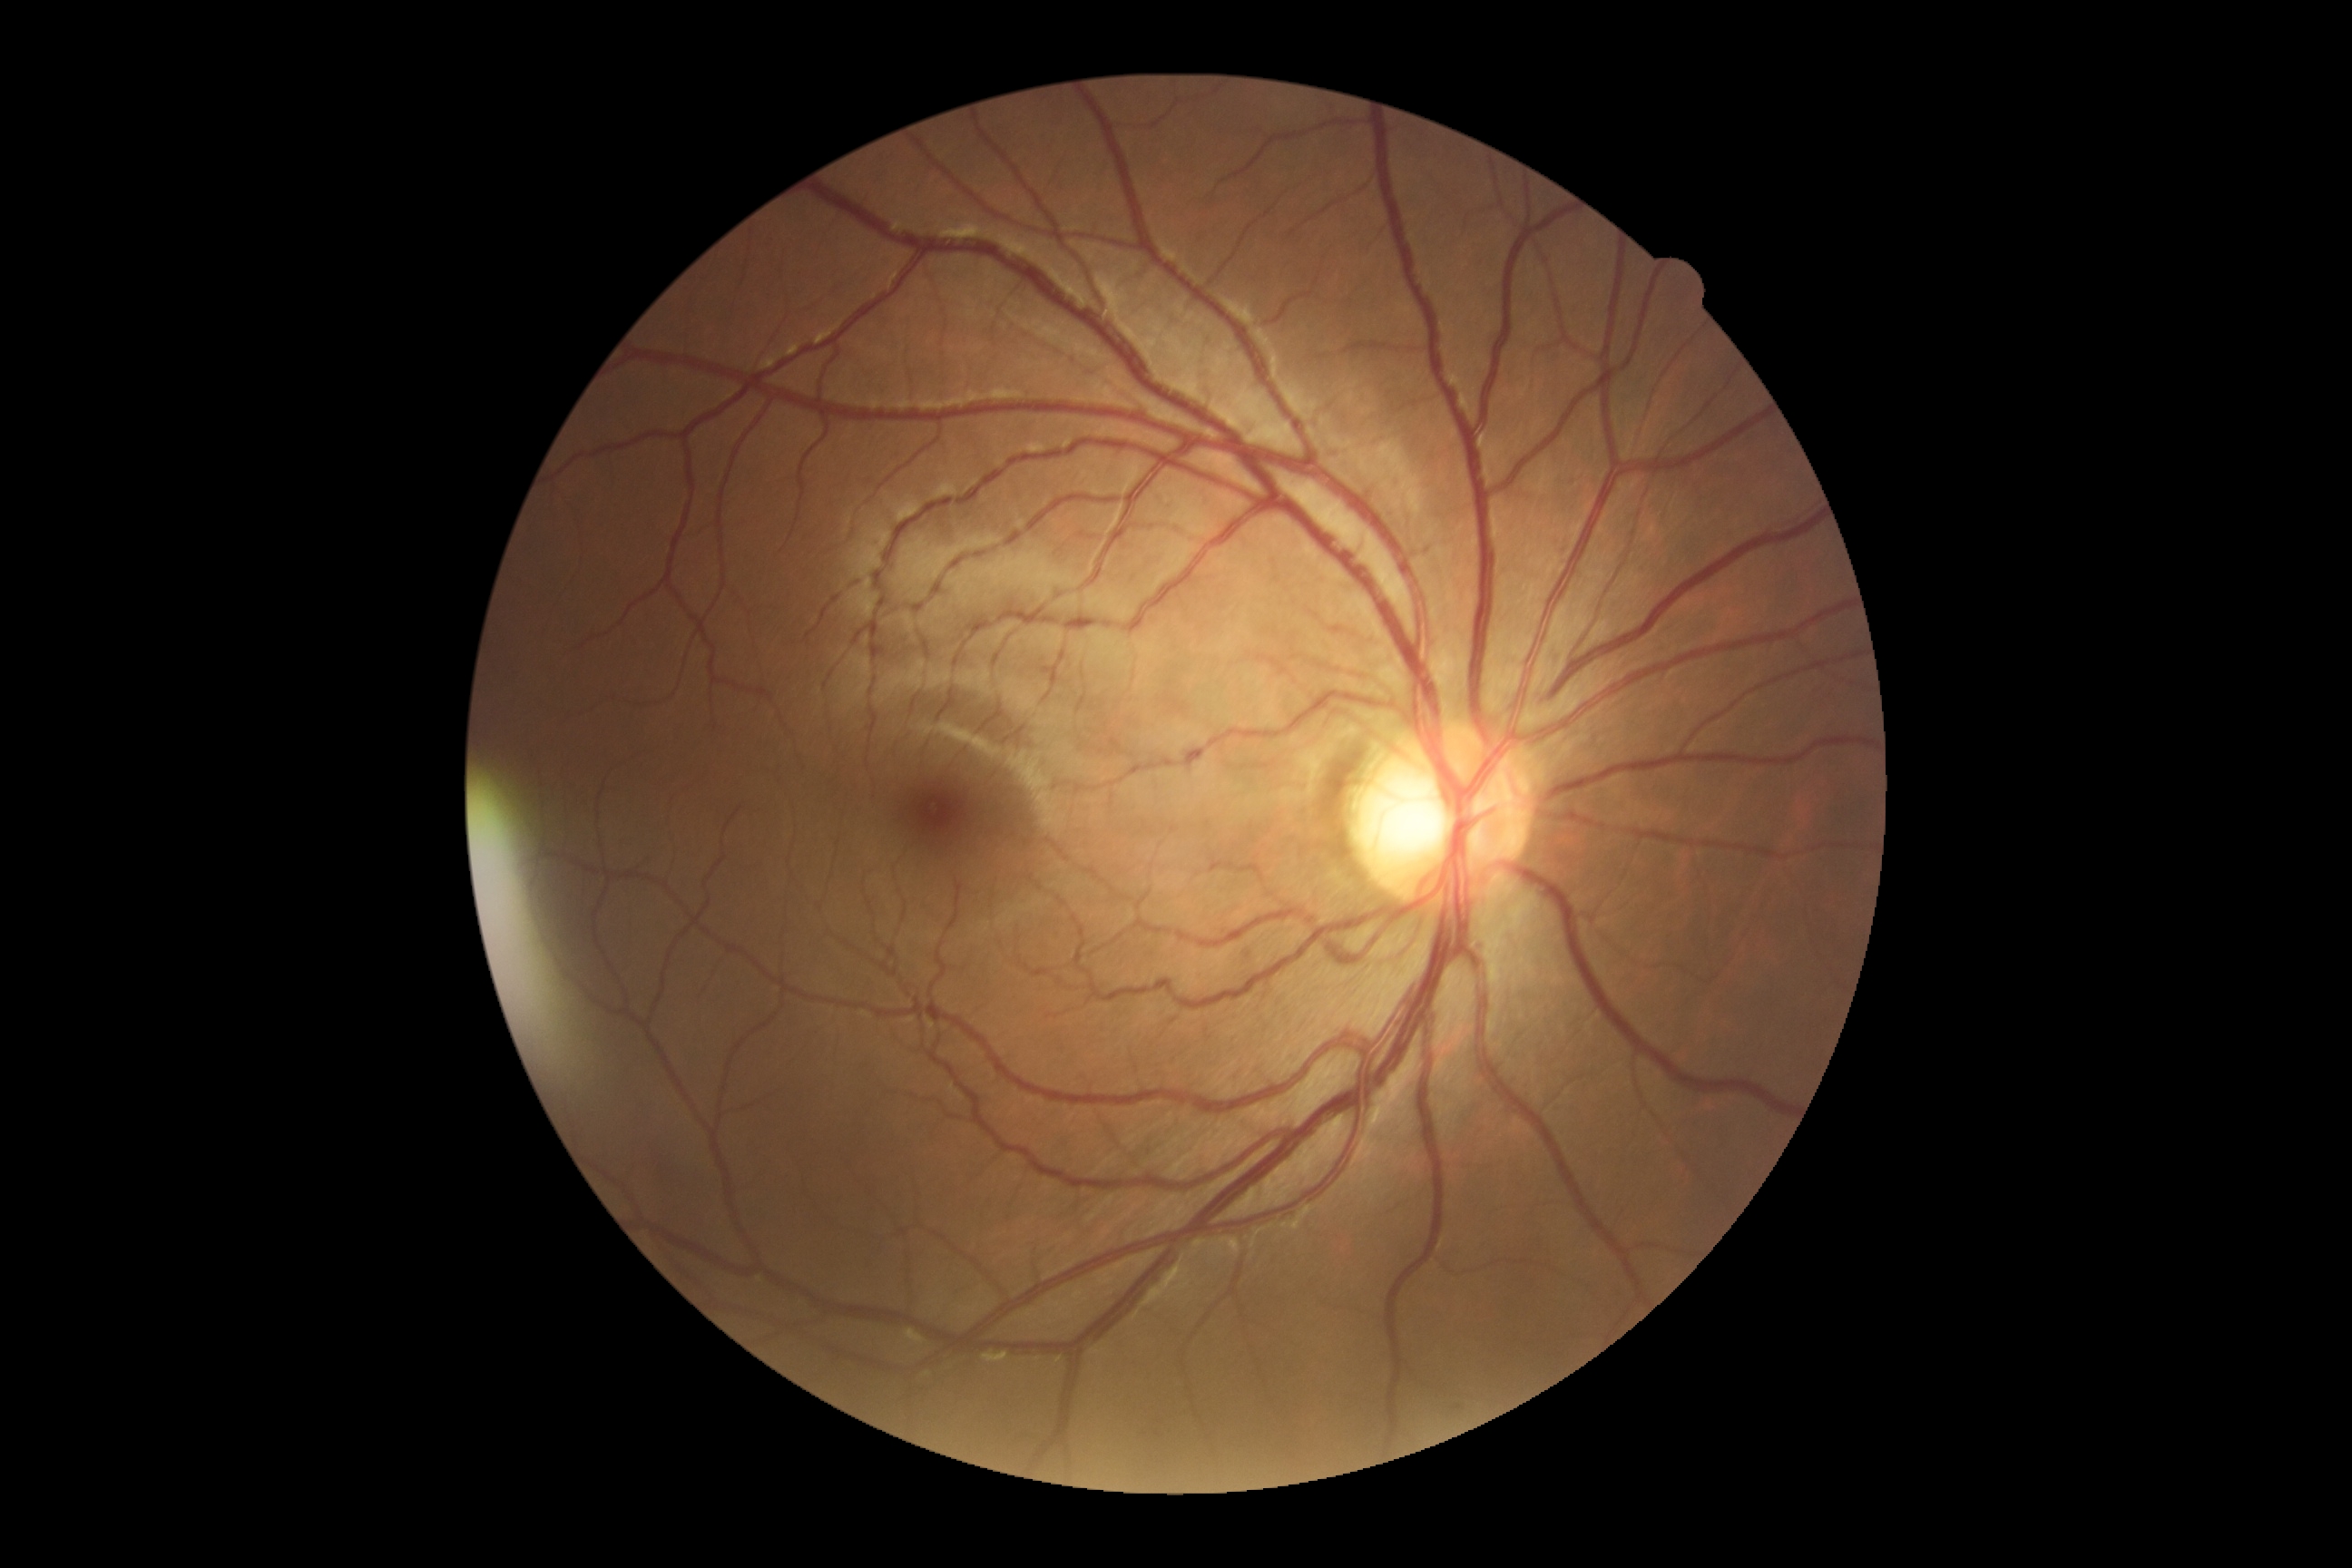

DR is no apparent retinopathy (grade 0) — no visible signs of diabetic retinopathy.